FOV: 50 degrees: 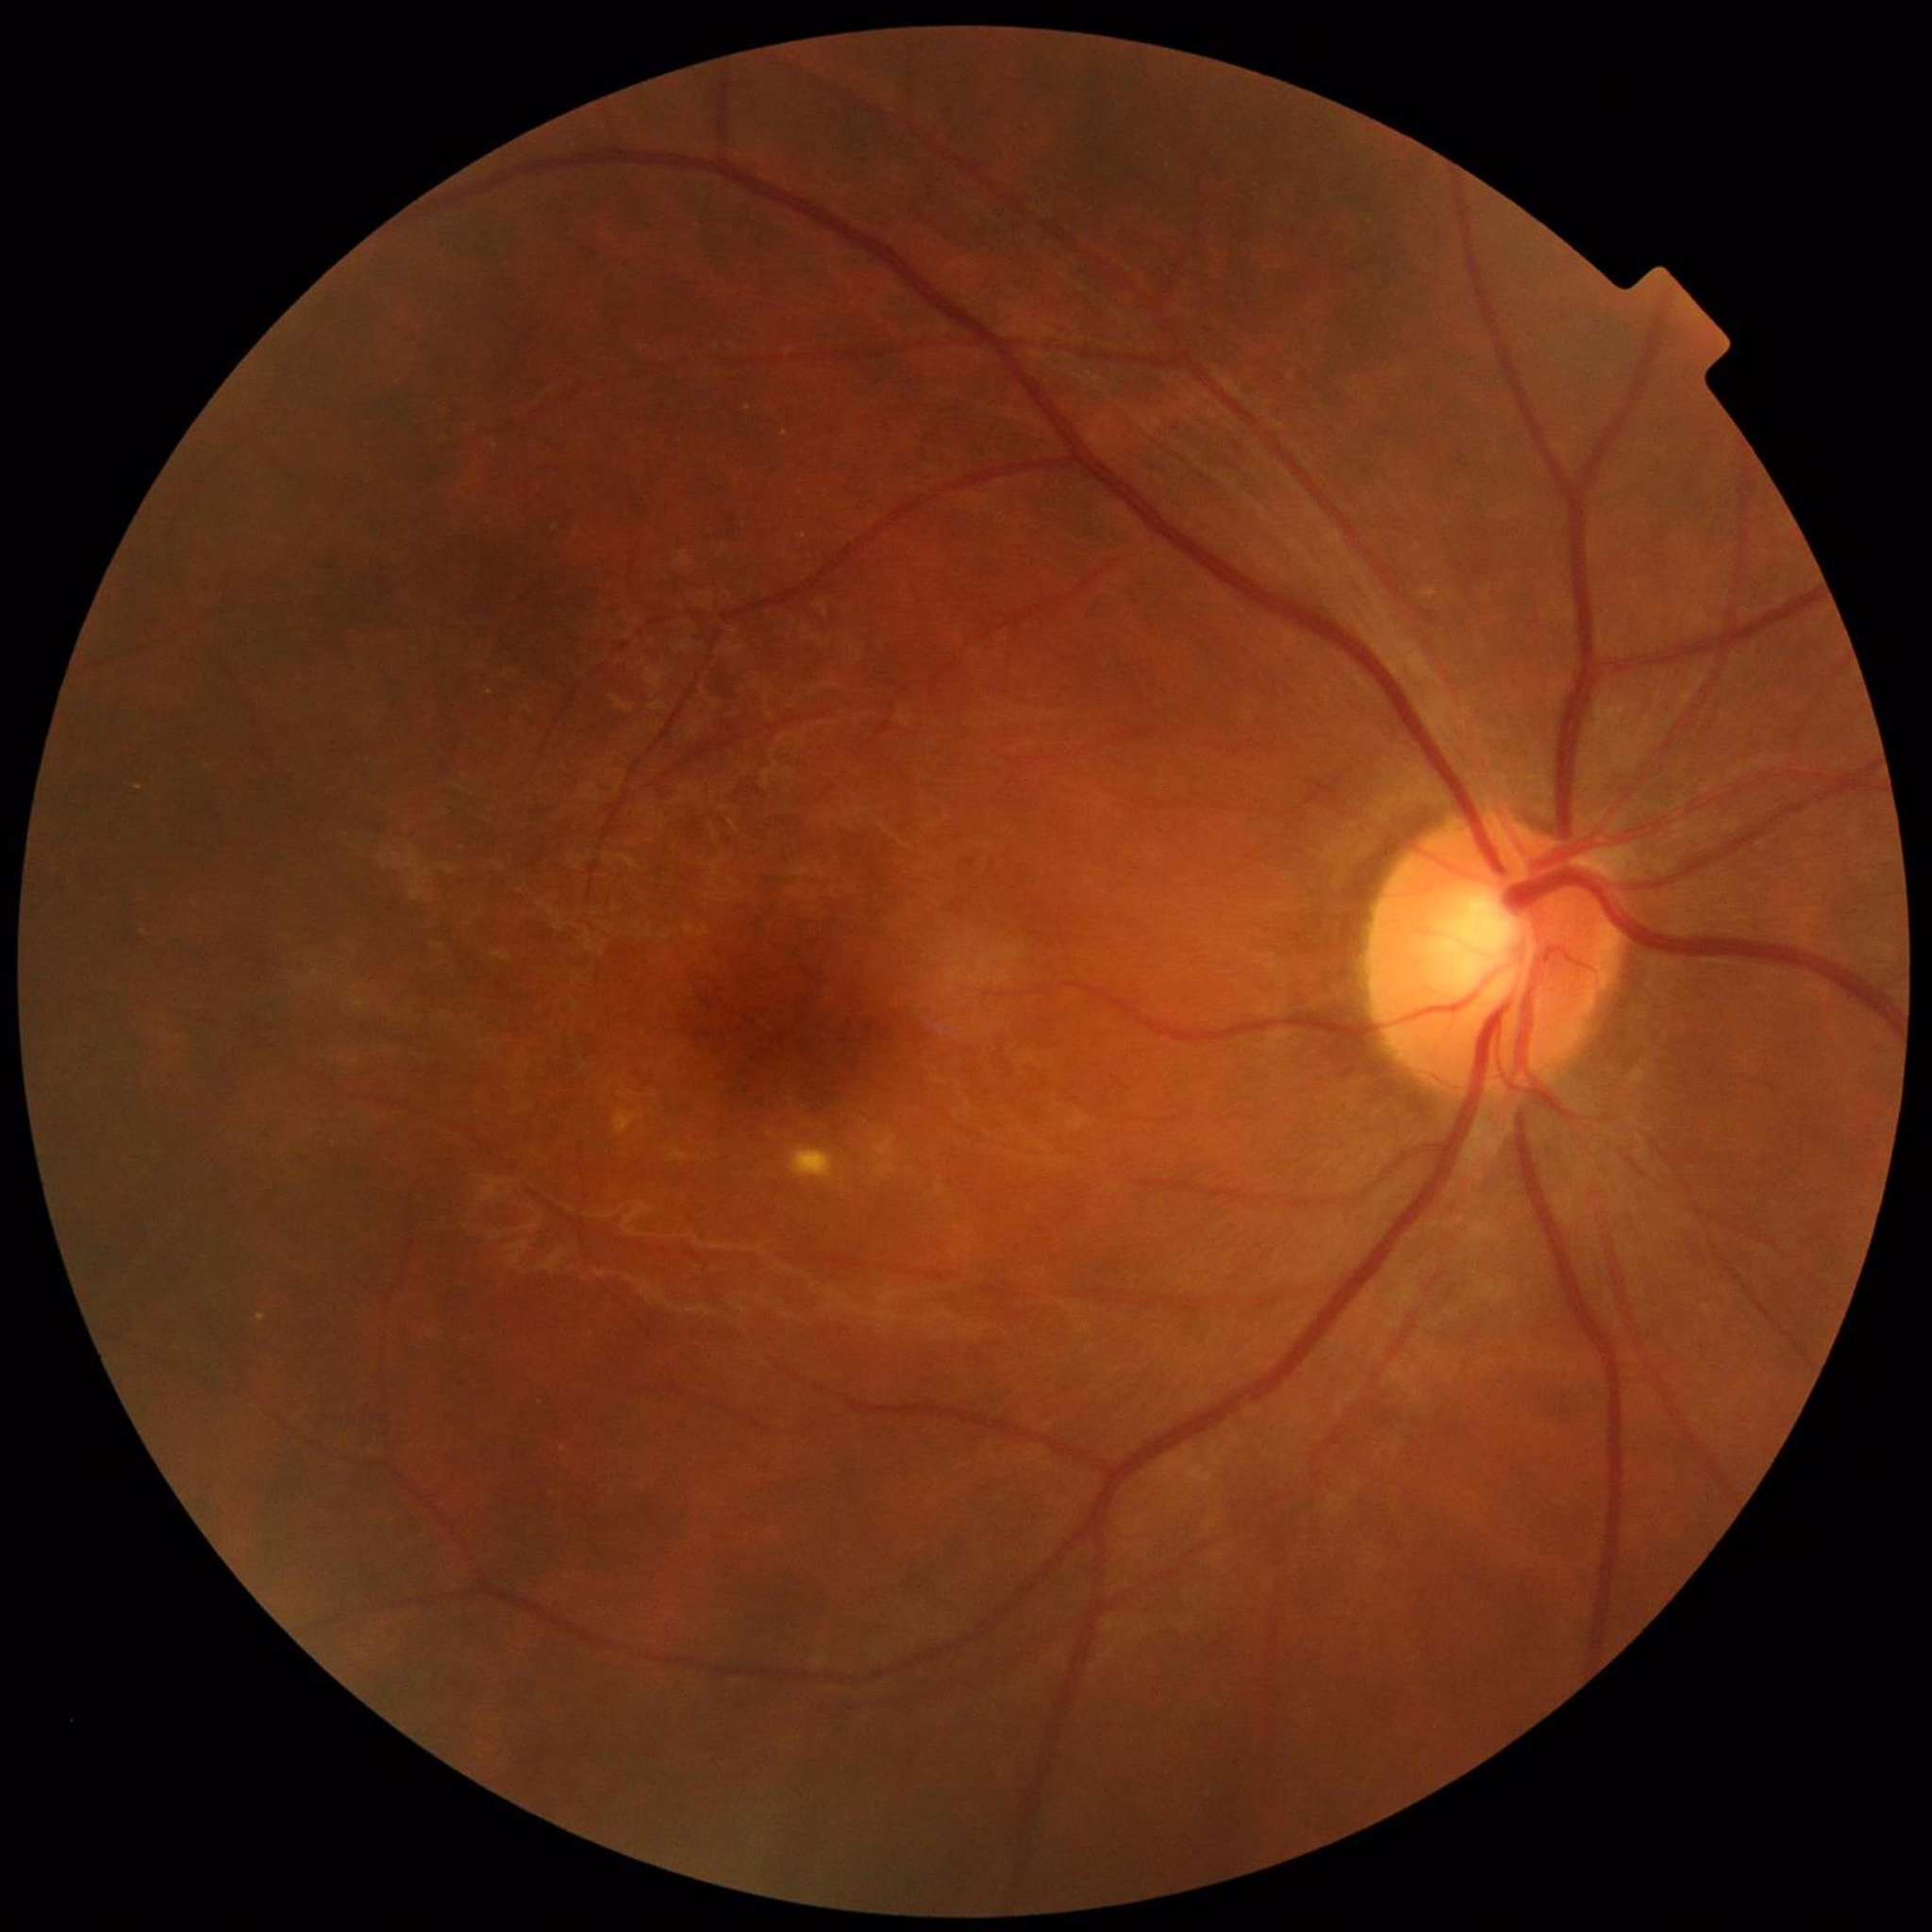
Image quality: no quality issues identified; Condition: age-related macular degeneration.